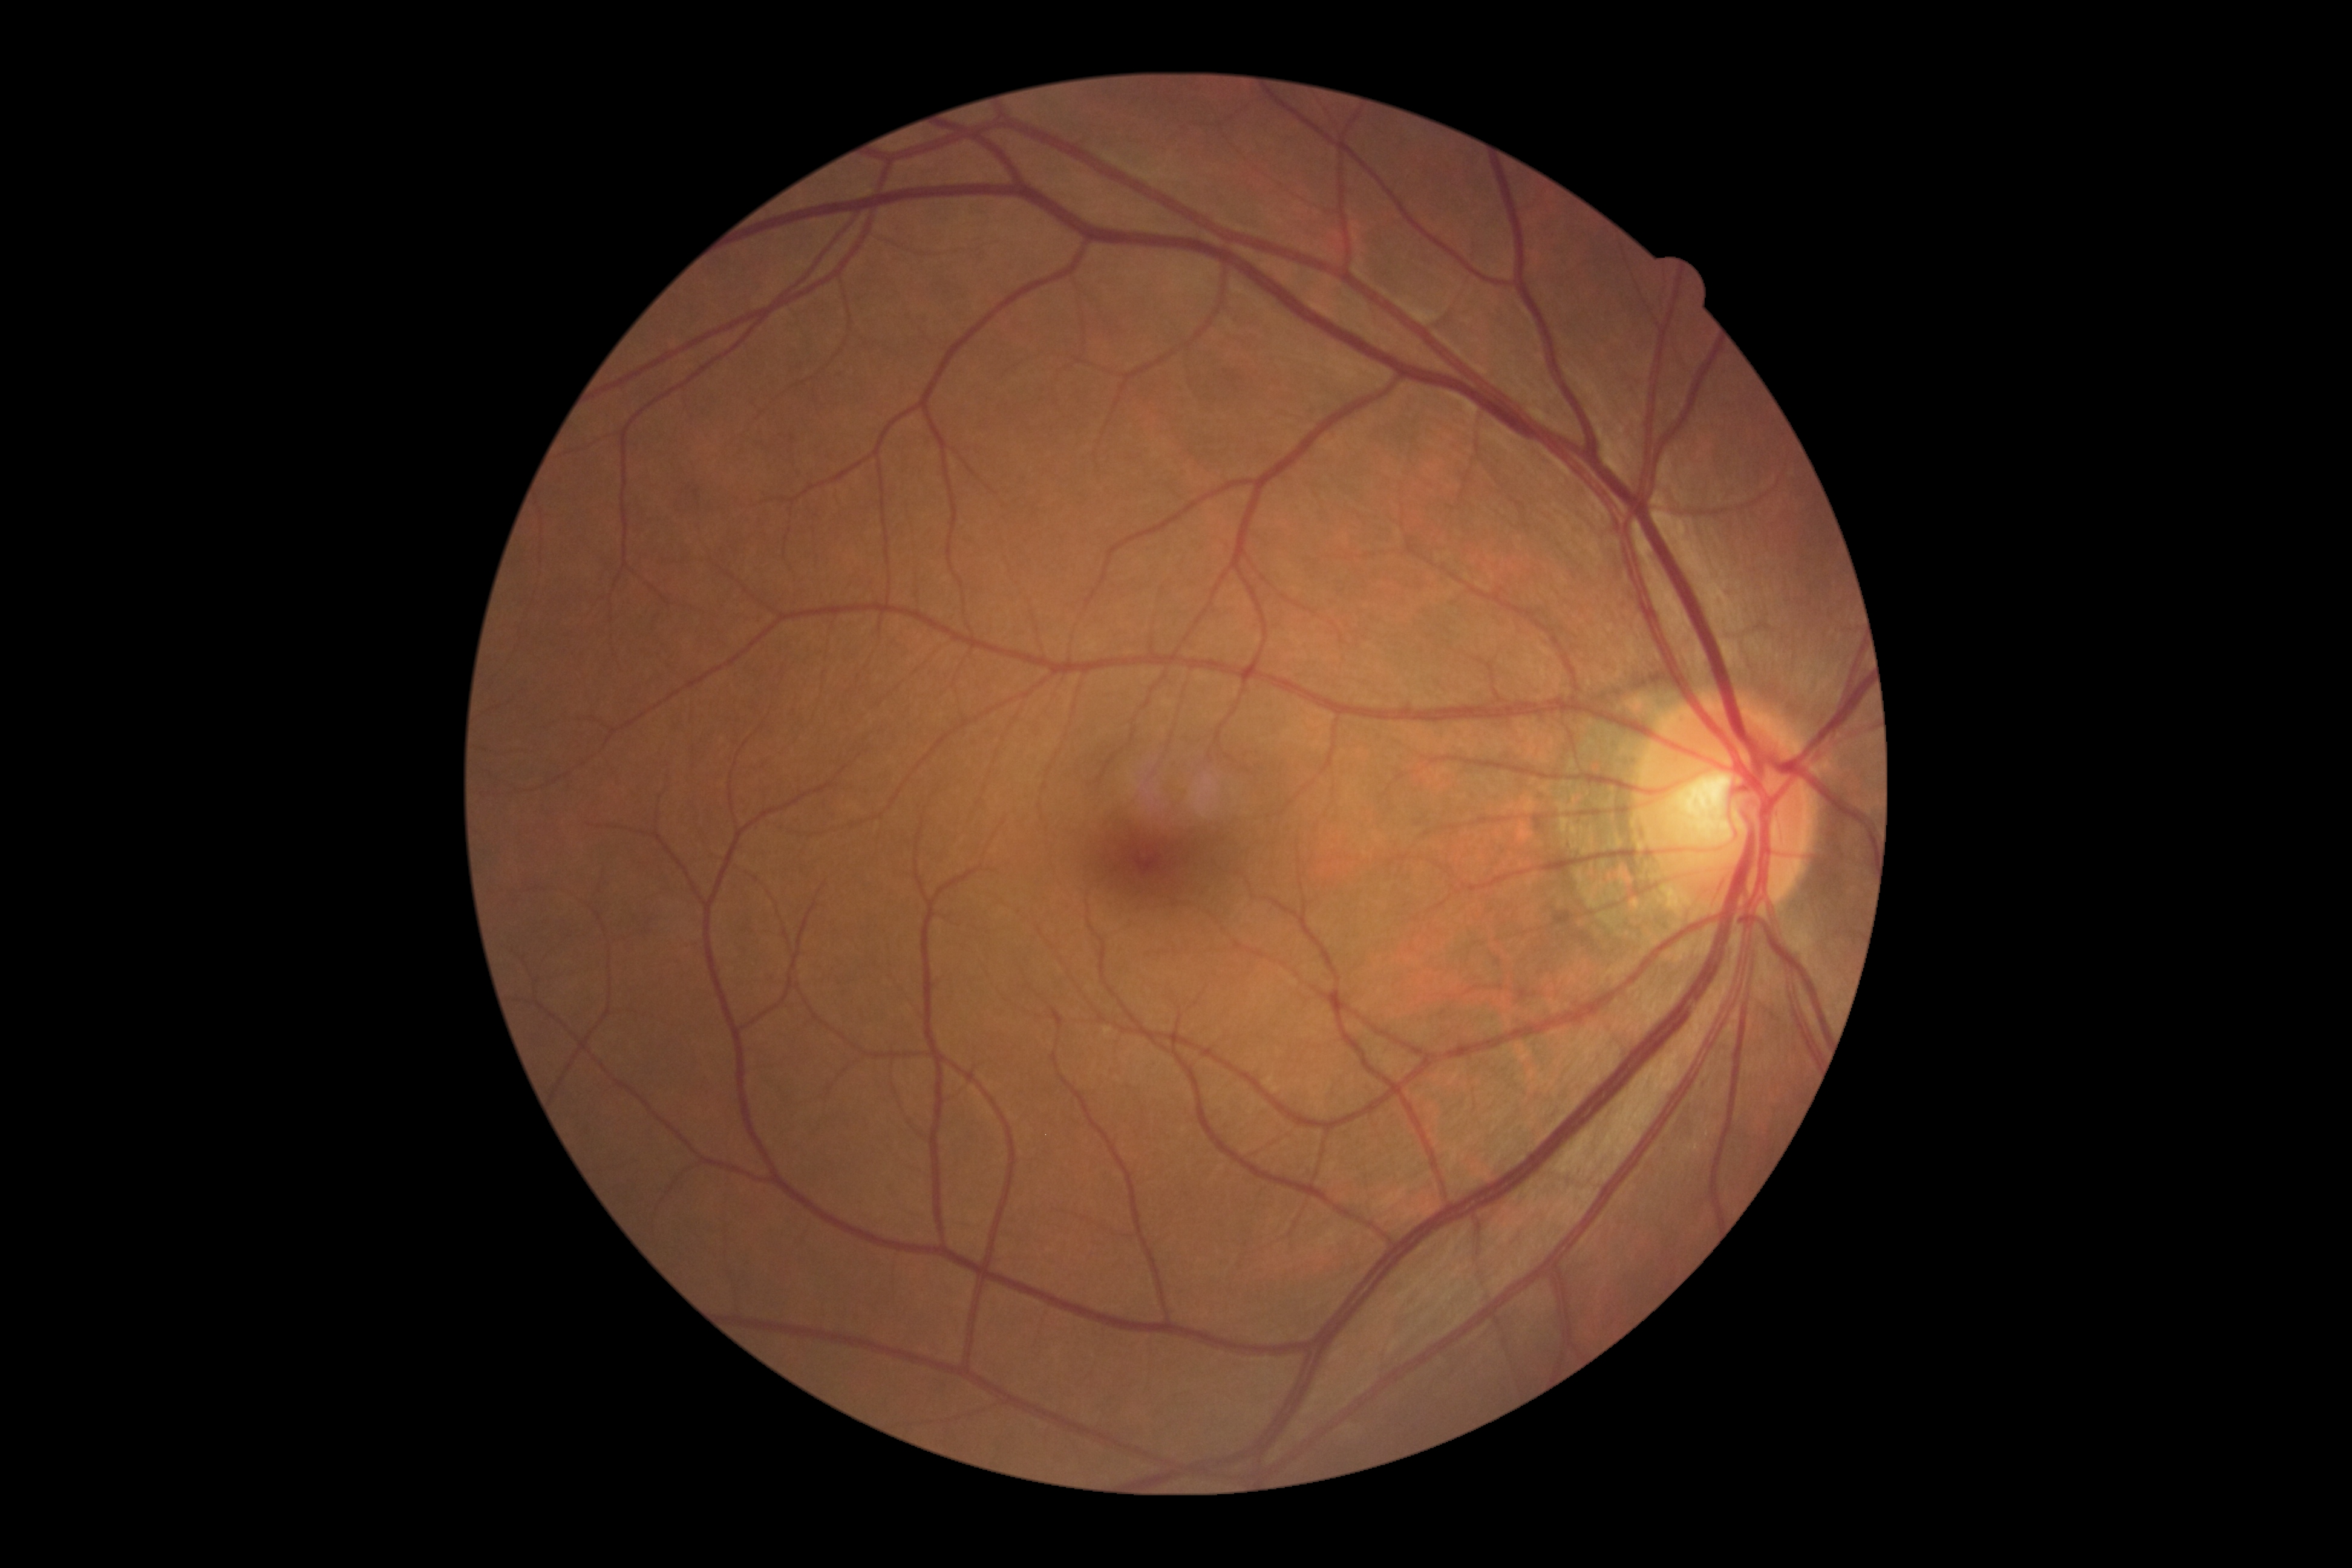
DR is 0. No diabetic retinal disease findings.